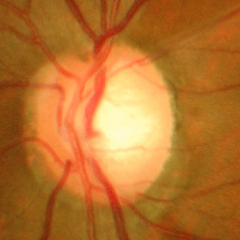
Advanced glaucomatous optic neuropathy.